Mydriatic. 295 by 295 pixels. Color fundus photograph centered on the optic disc
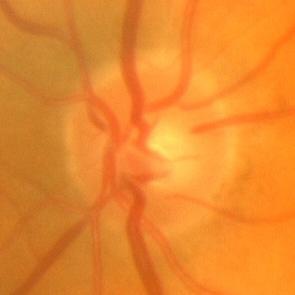 The image shows no glaucoma.